Wide-field contact fundus photograph of an infant:
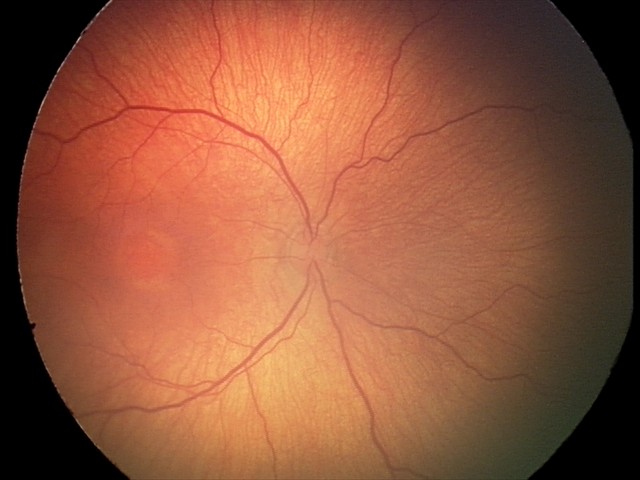 Plus disease absent. Screening series with retinopathy of prematurity (ROP) stage 2.